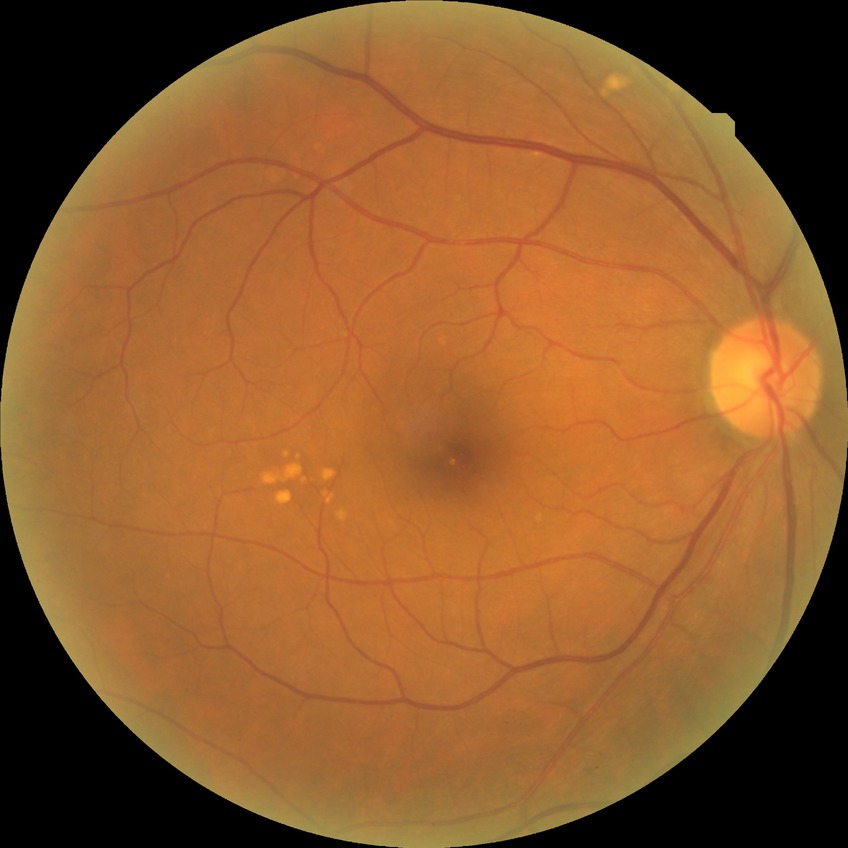

Diabetic retinopathy (DR): NDR (no diabetic retinopathy).